45° field of view, 1932 x 1932 pixels:
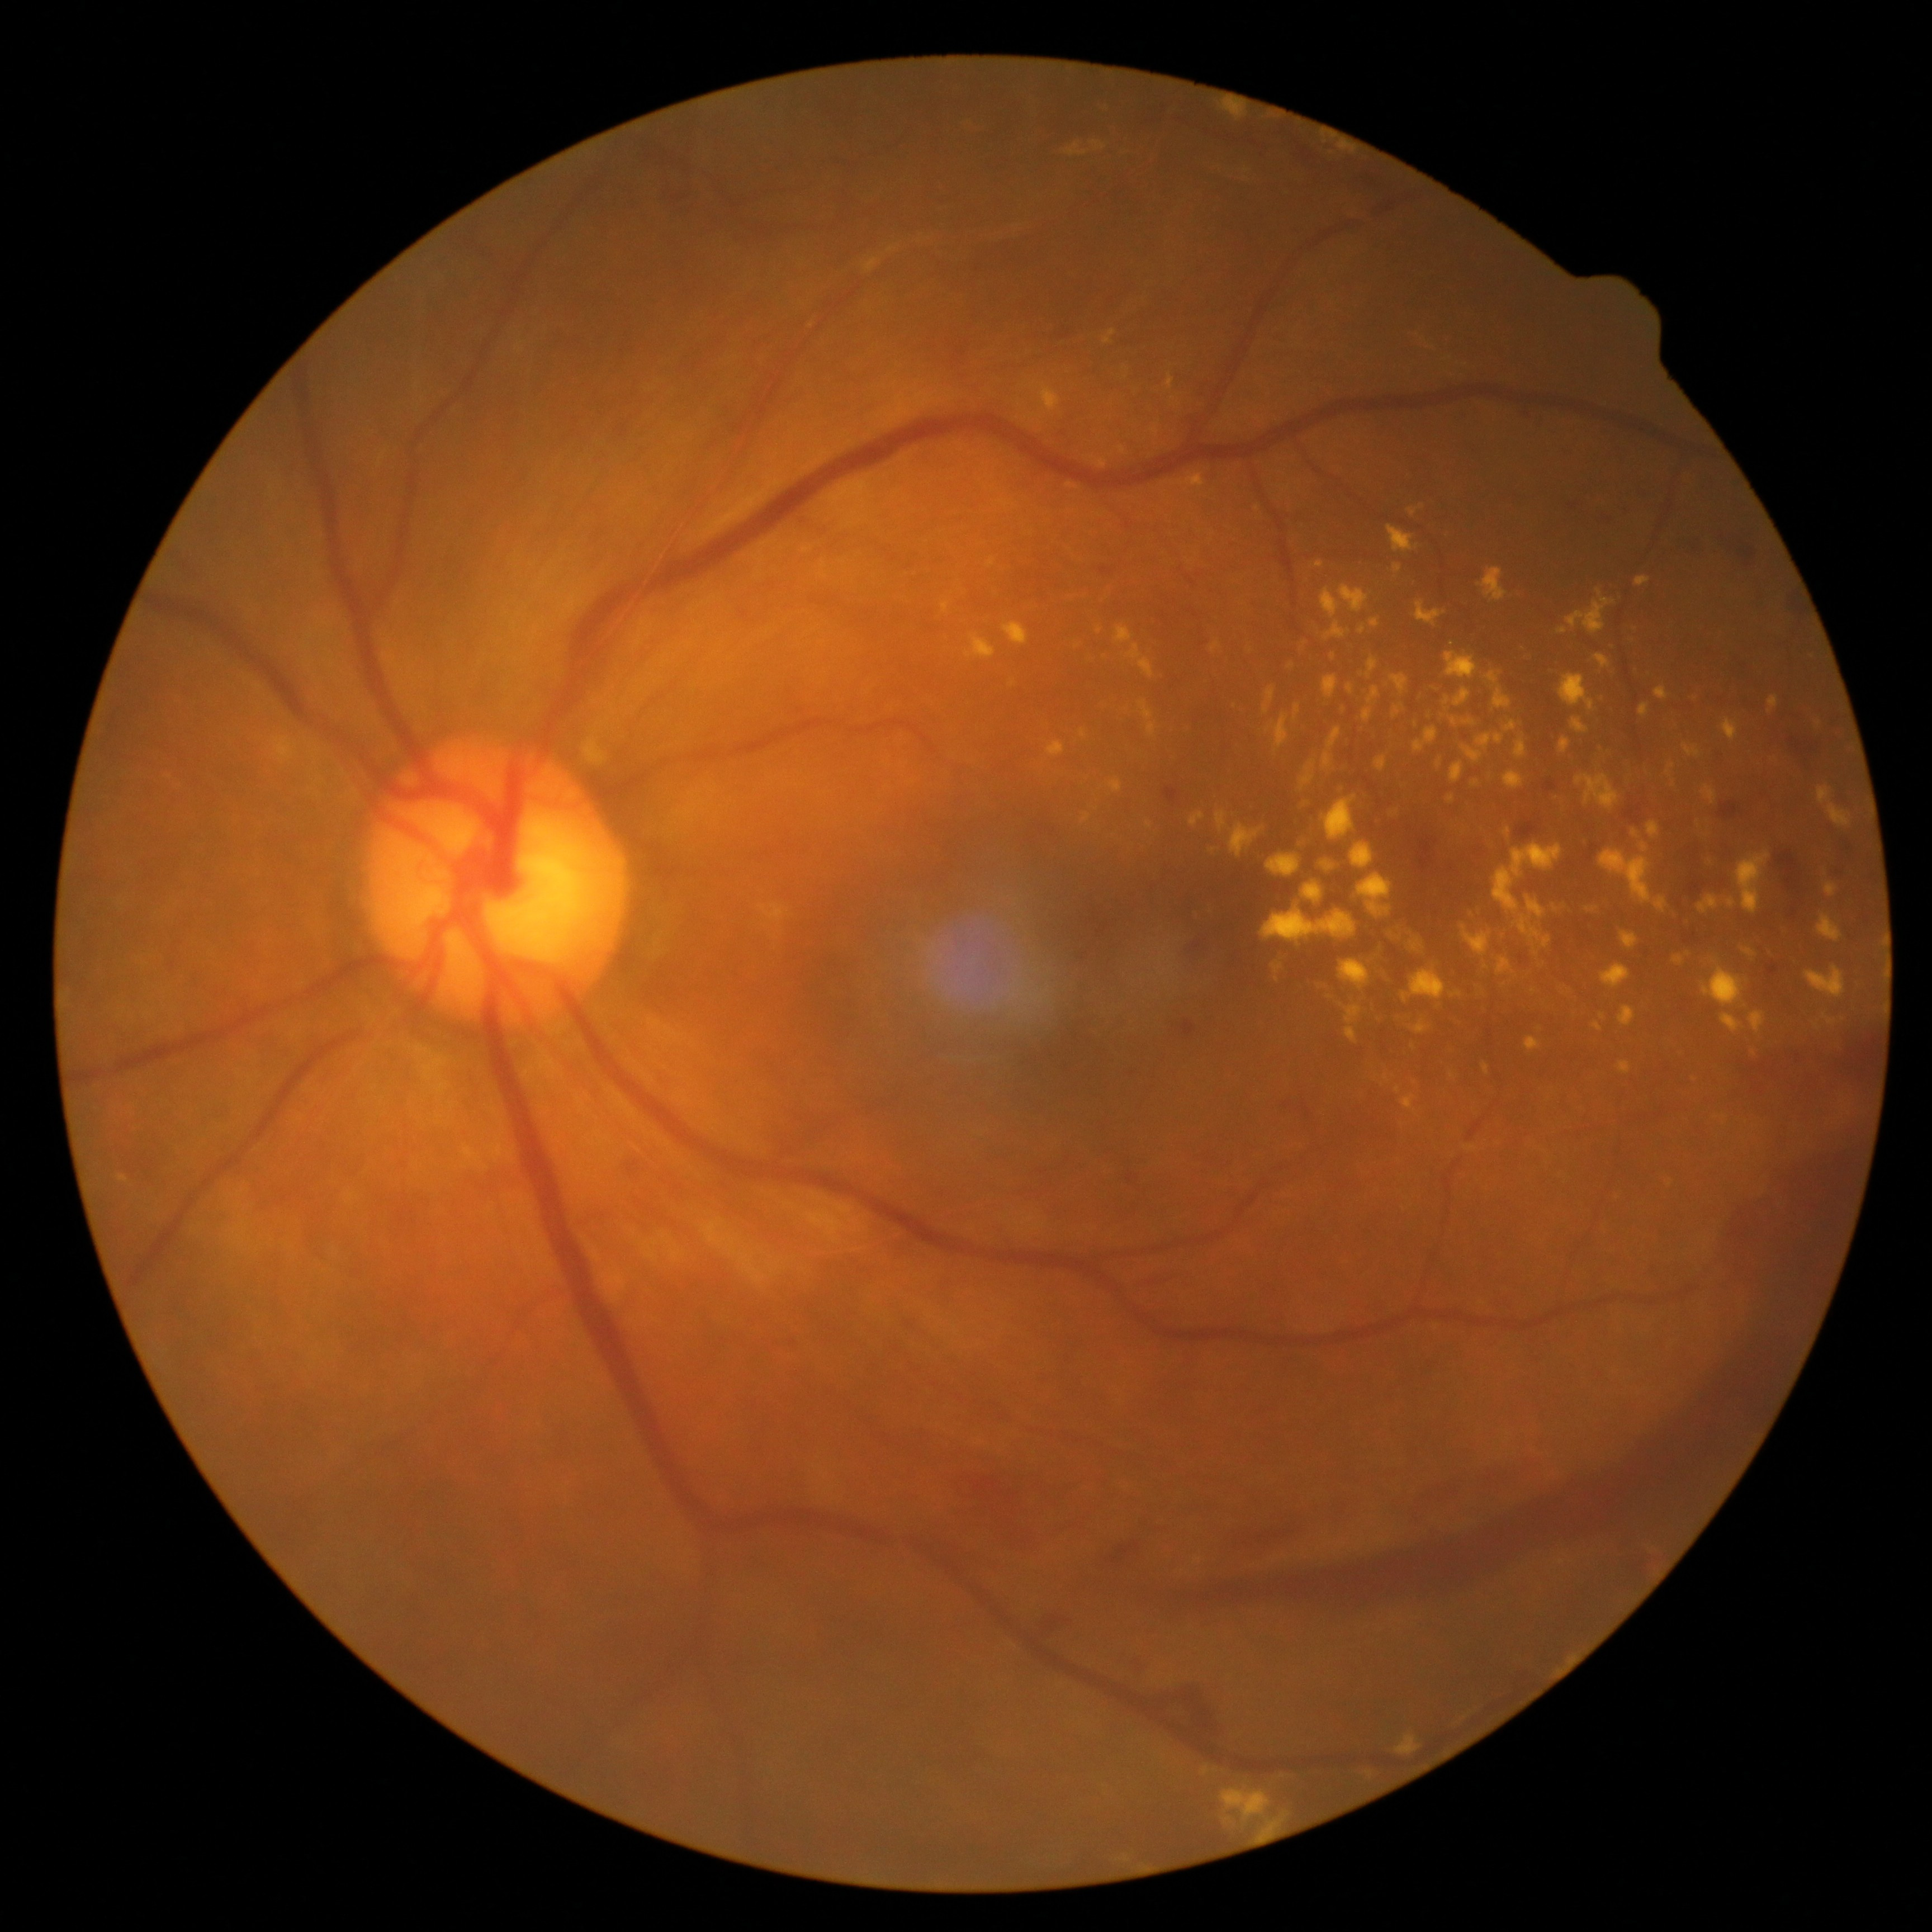 Diabetic retinopathy grade is 4
Lesions identified (partial list):
hard exudates (partial) = [1295,830,1315,850], [1152,428,1159,437], [1824,882,1839,898], [1346,685,1355,694], [1673,955,1684,967], [1558,629,1567,634], [1744,949,1755,958], [1310,981,1362,1044], [1451,717,1478,727], [964,634,996,659], [1375,756,1387,772], [1295,634,1309,658], [1685,685,1702,706], [1479,567,1508,602], [1002,623,1029,645], [1323,795,1357,840], [1699,954,1718,963]
Small hard exudates approximately at (1344,710), (1126,369), (1334,656)